1659x2212px:
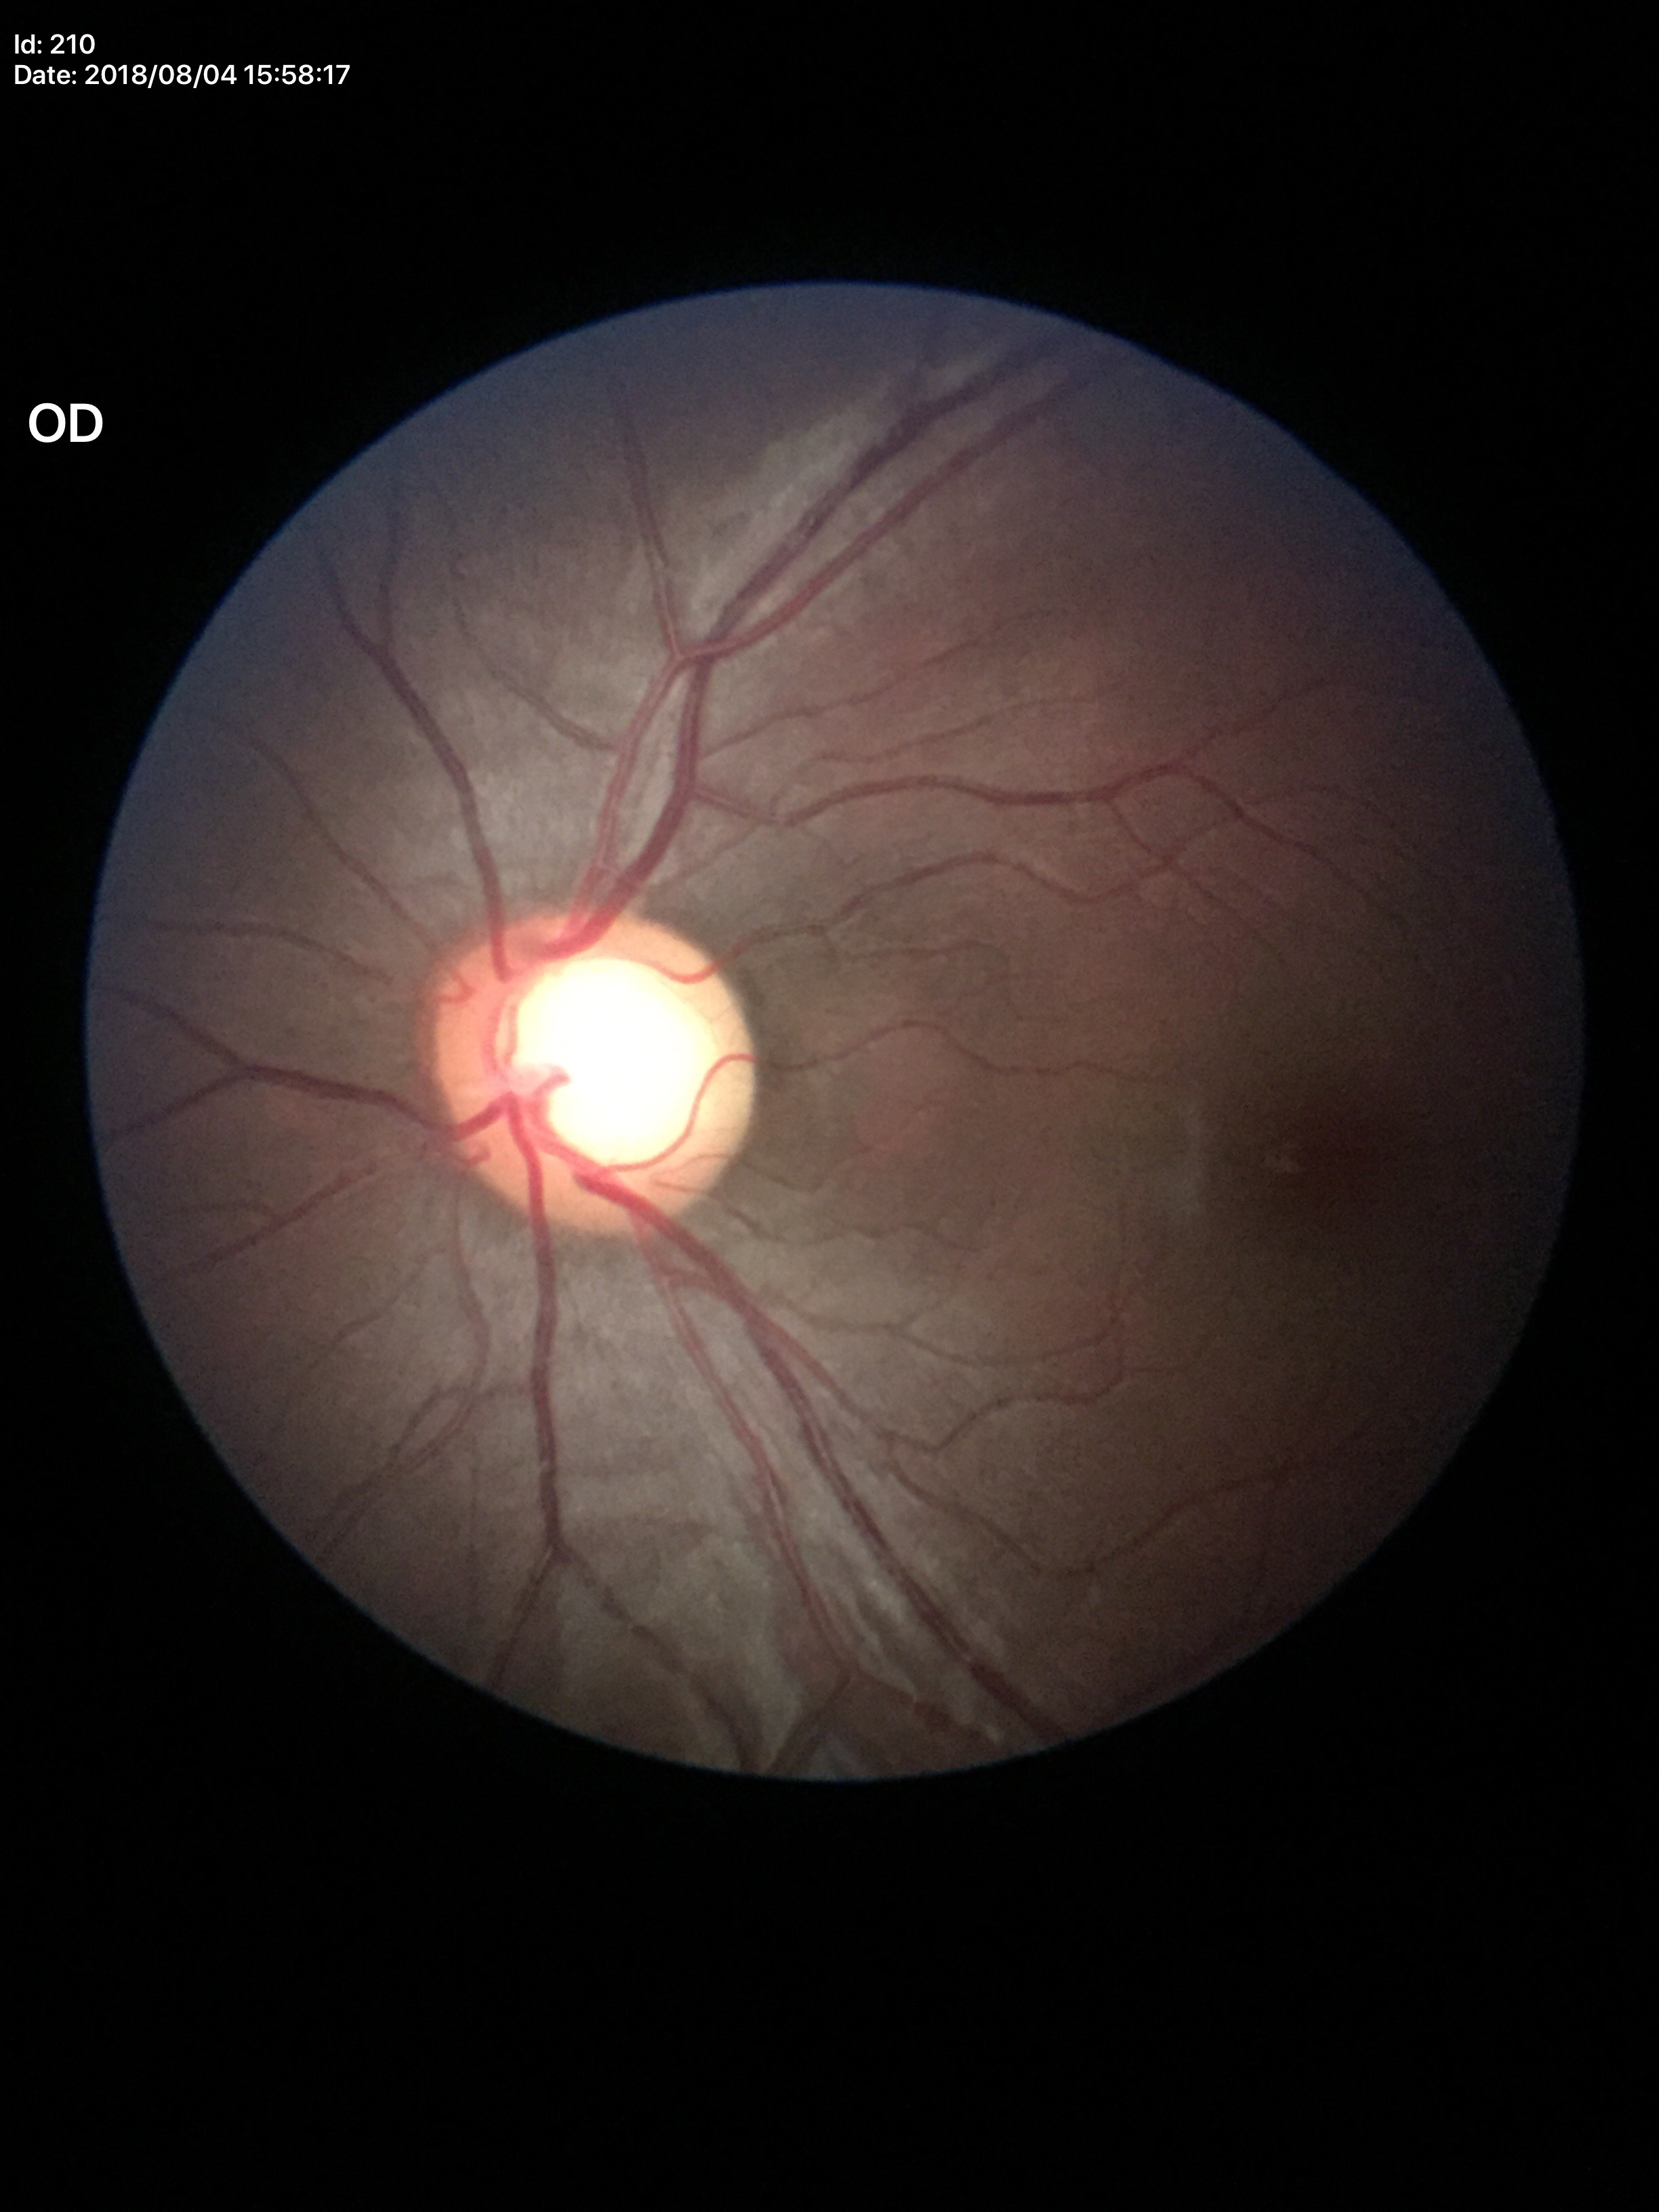

Glaucoma-suspect optic disc appearance. Vertical CDR (VCDR): 0.66. Horizontal C/D ratio (HCDR) of 0.67.